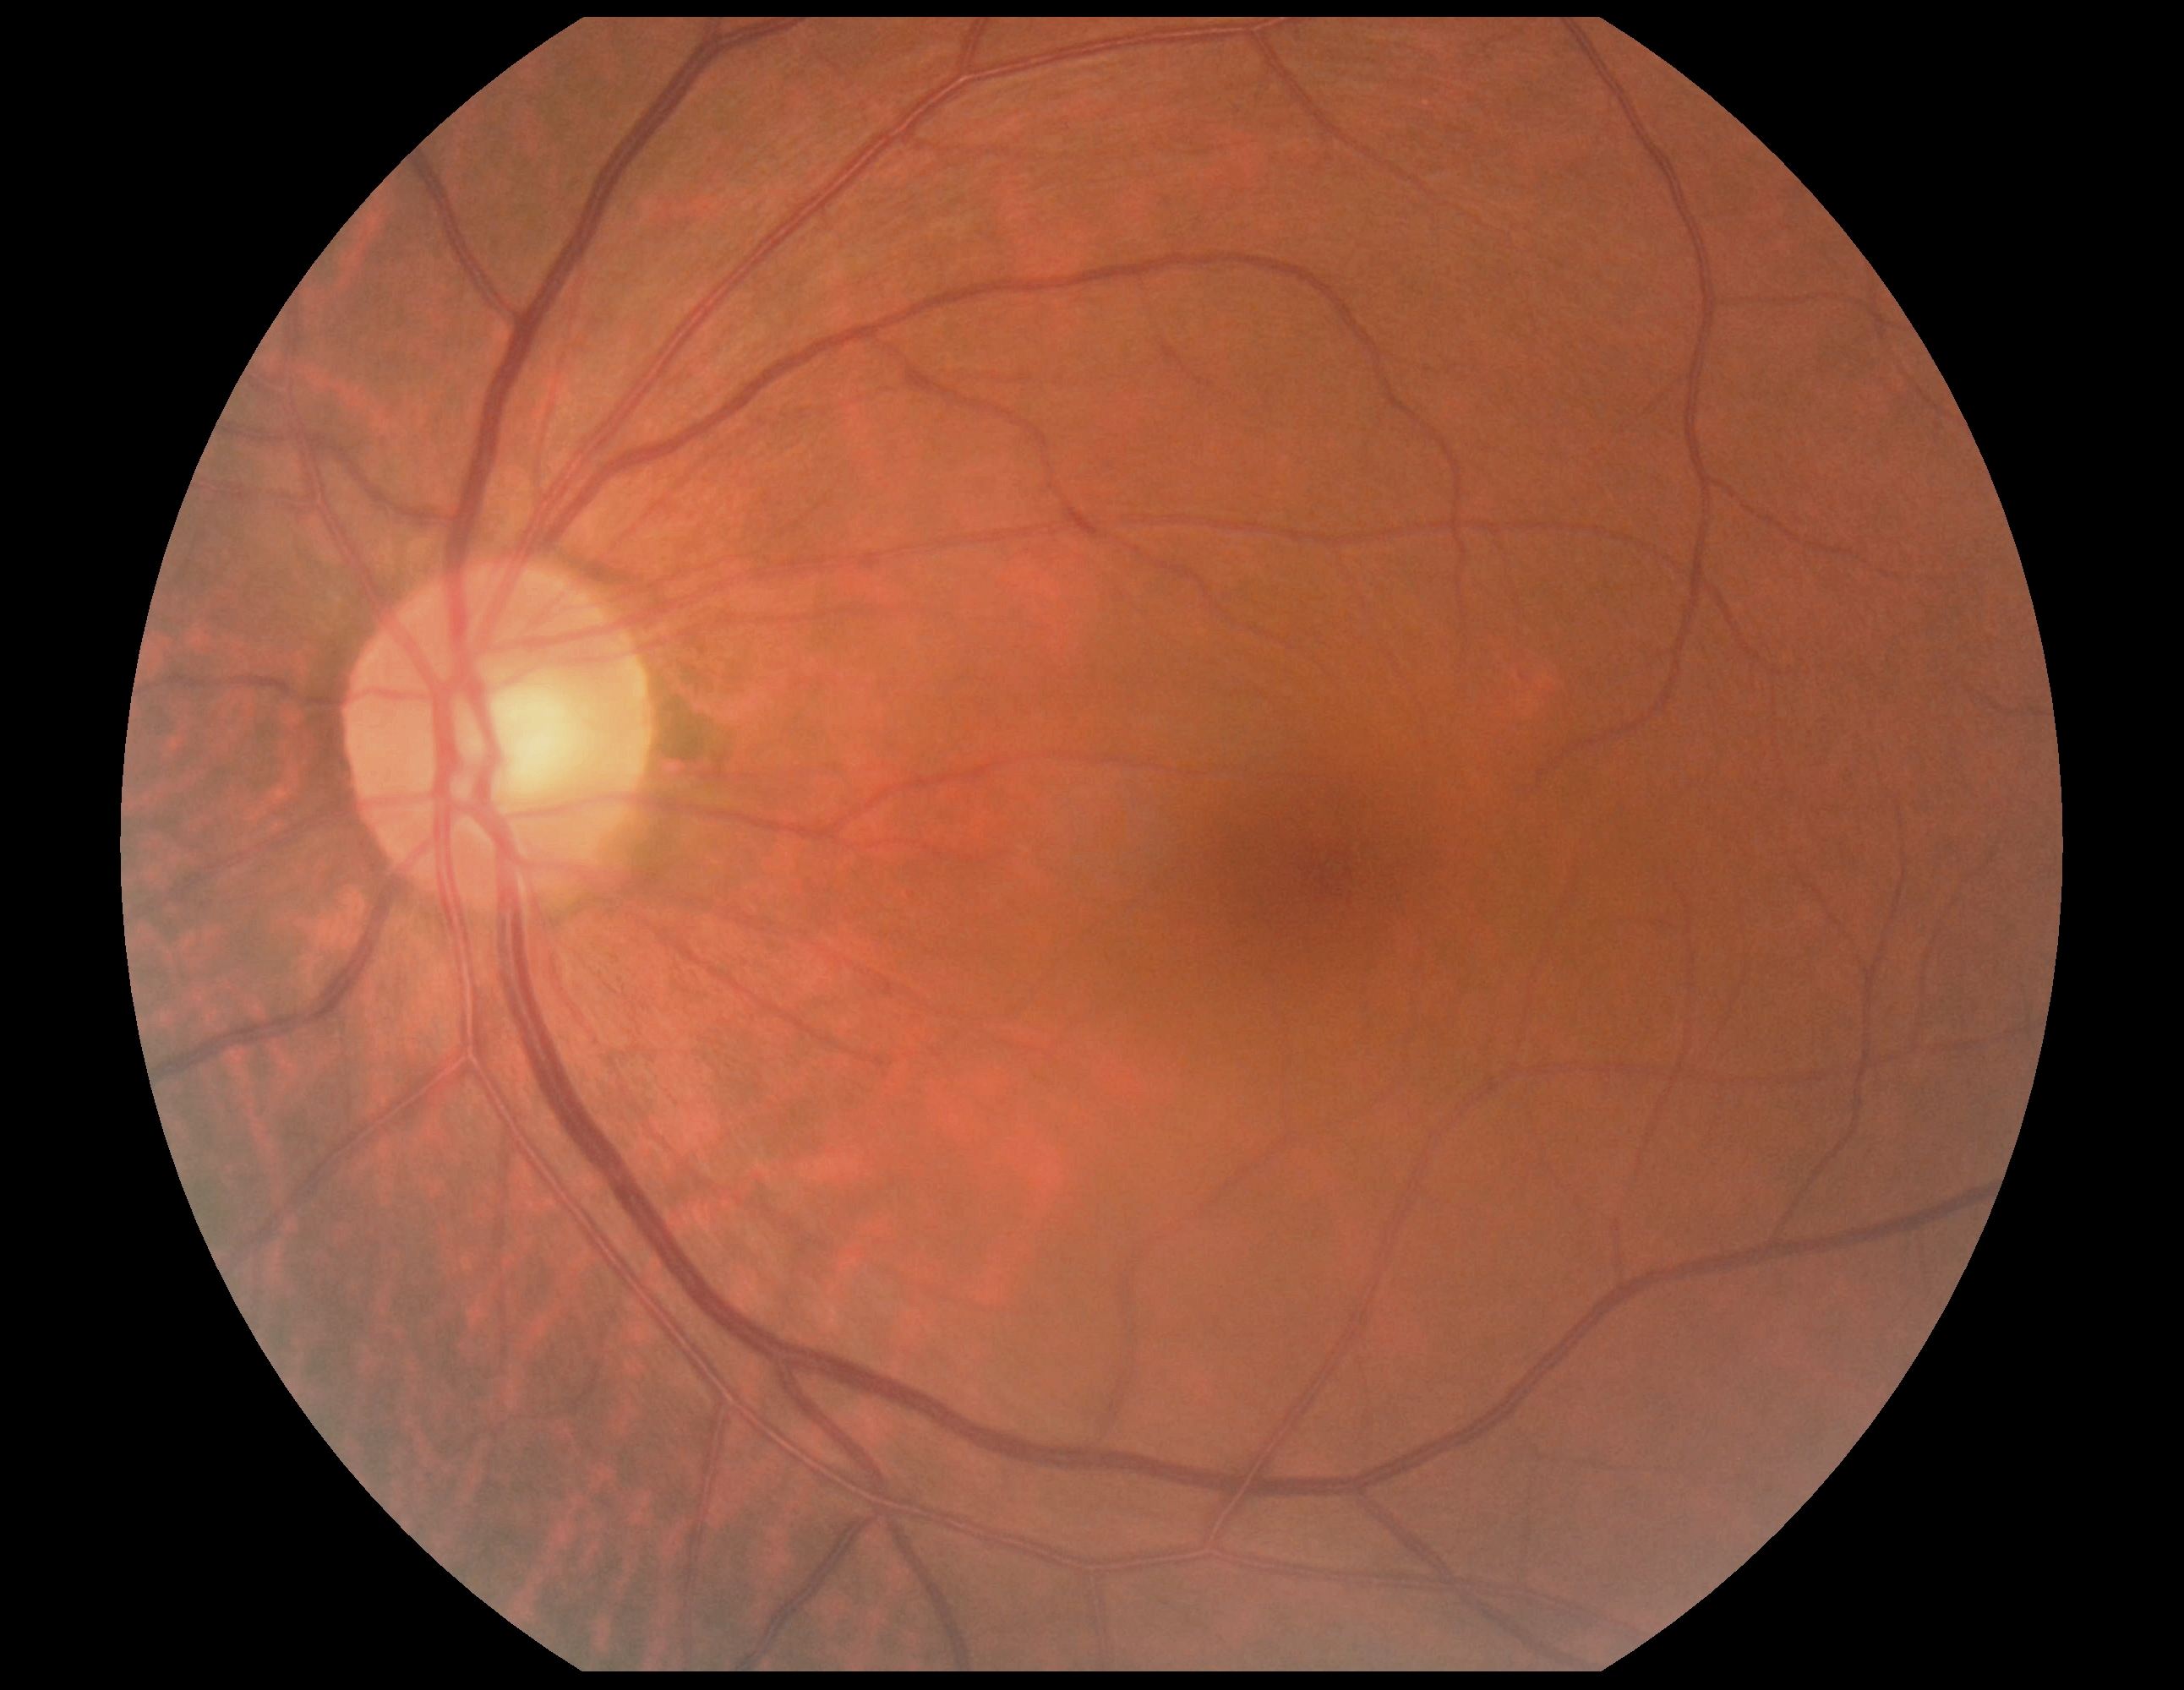 No apparent diabetic retinopathy. DR: grade 0 (no apparent retinopathy) — no visible signs of diabetic retinopathy.